Captured on a Topcon TRC-NW8 fundus camera.
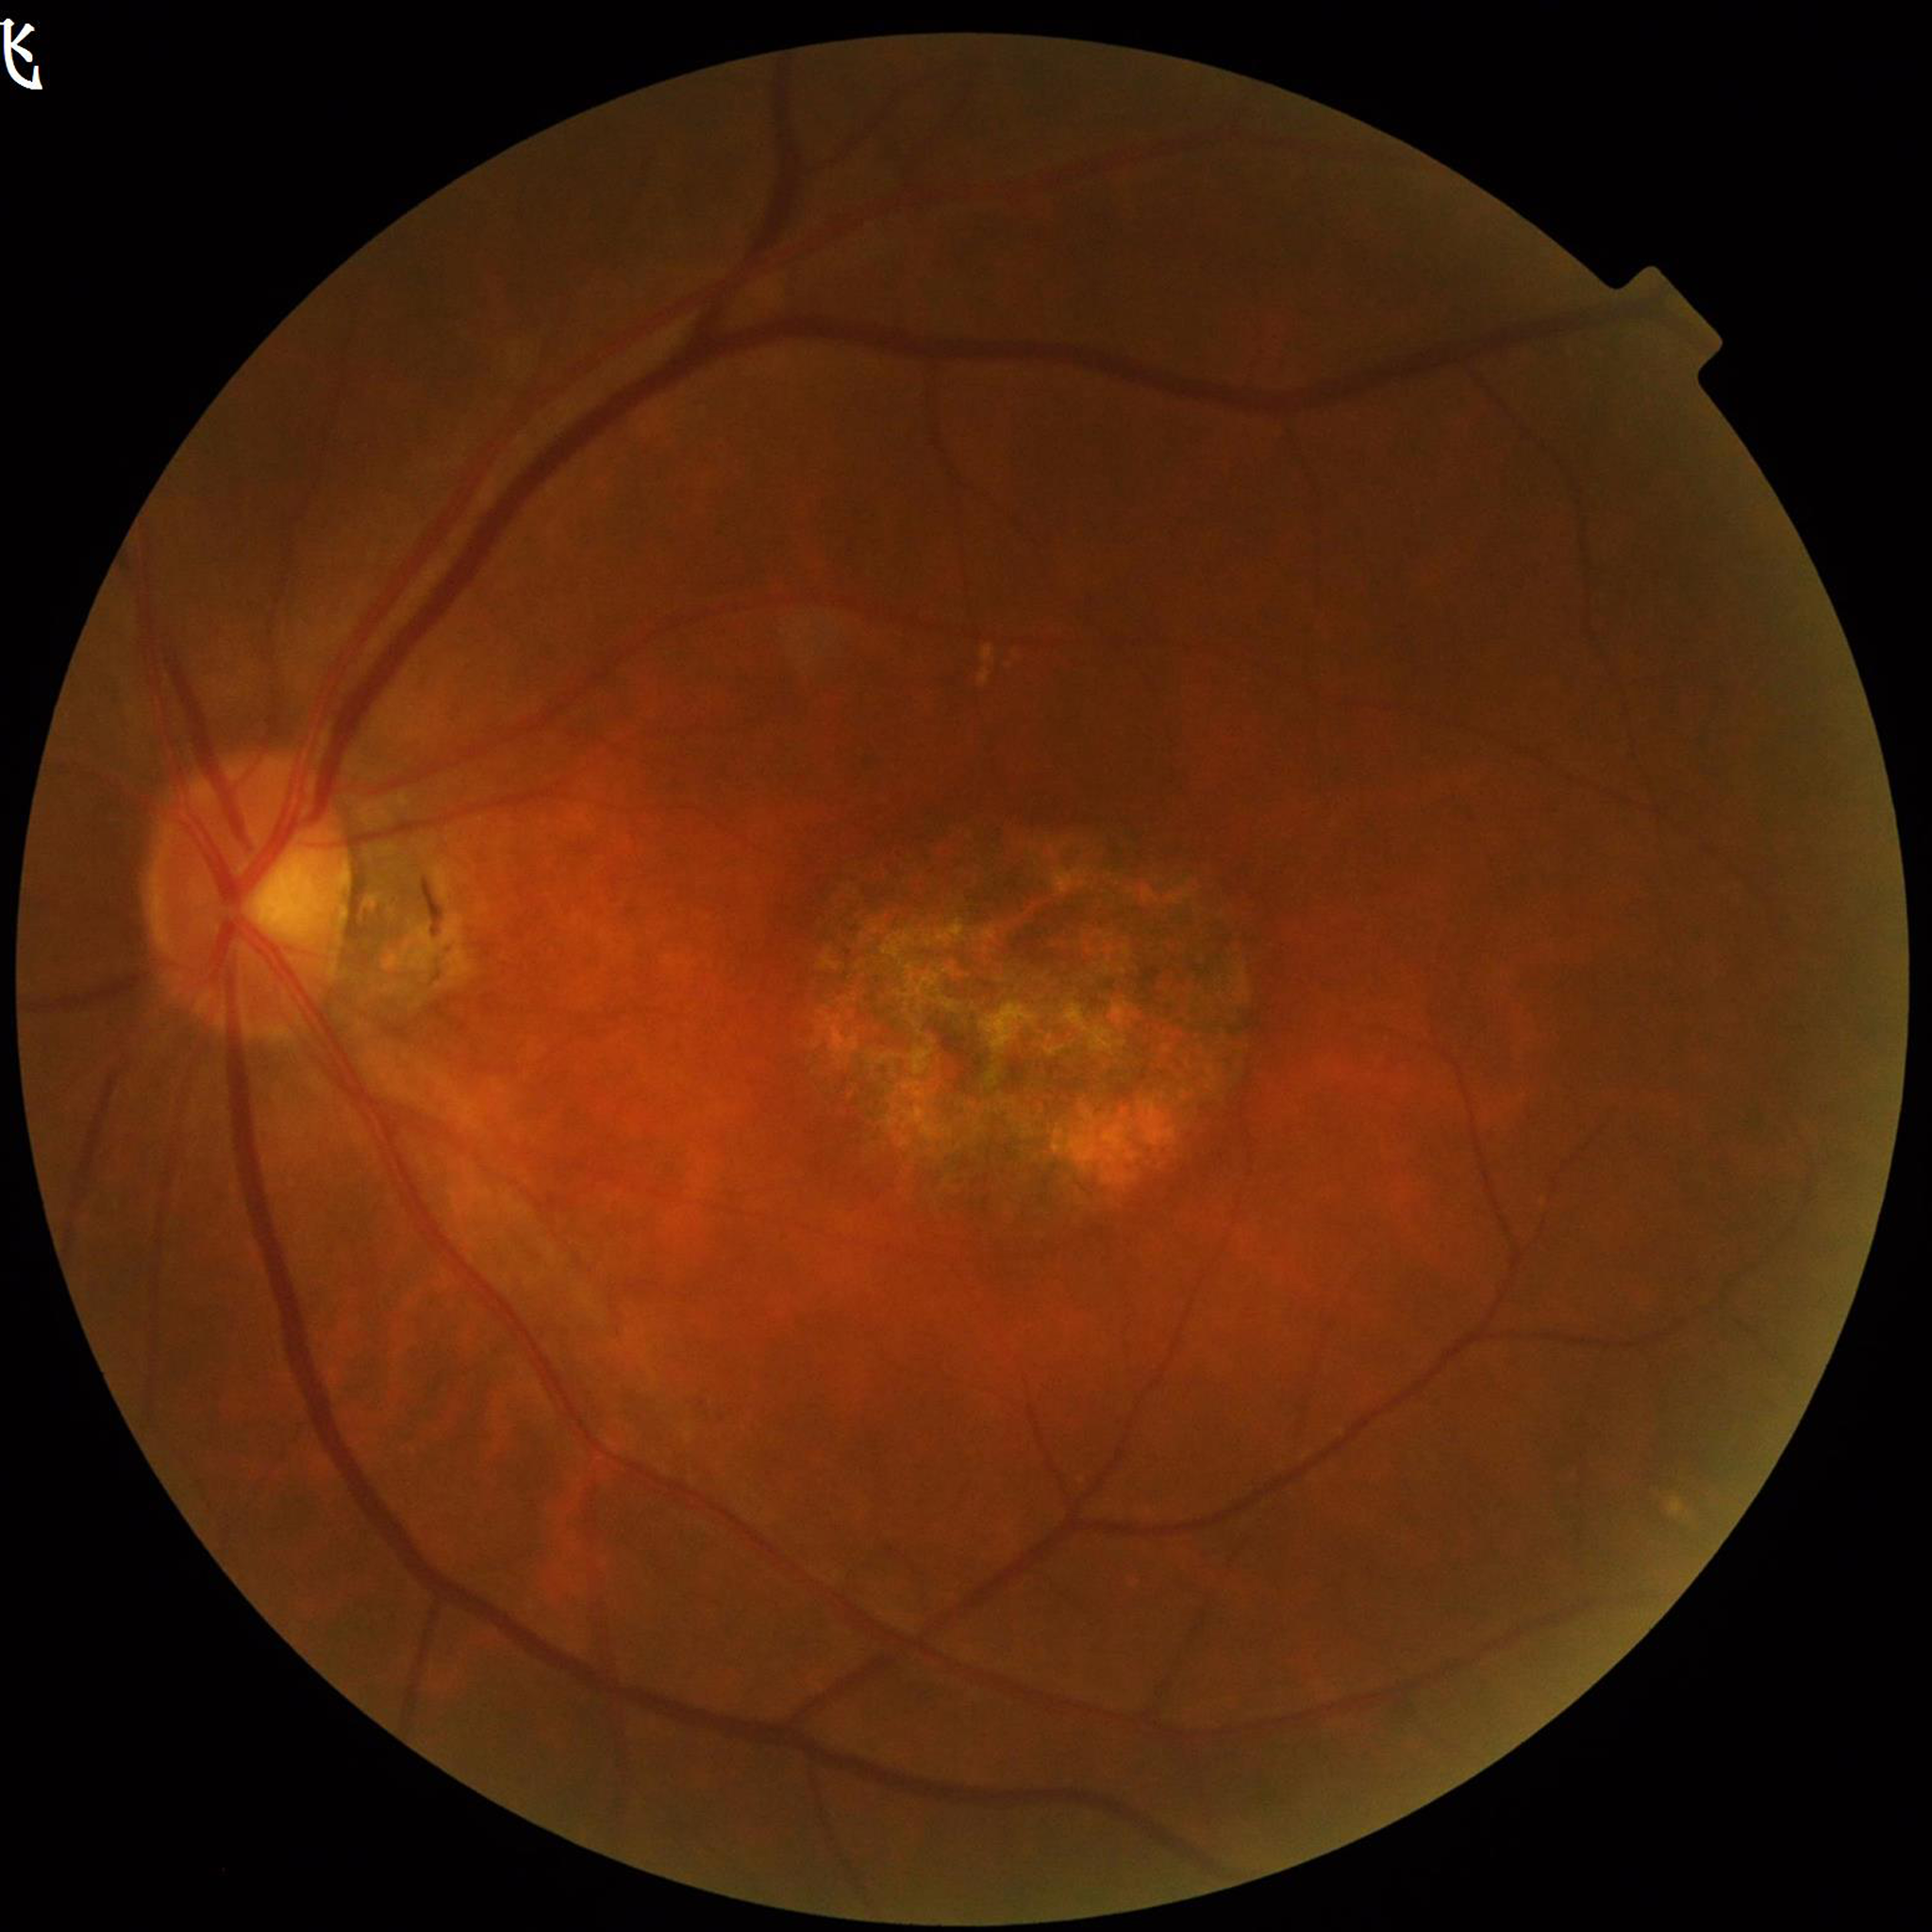 Diagnosis: AMD.